Posterior pole color fundus photograph, 848 by 848 pixels, camera: NIDEK AFC-230
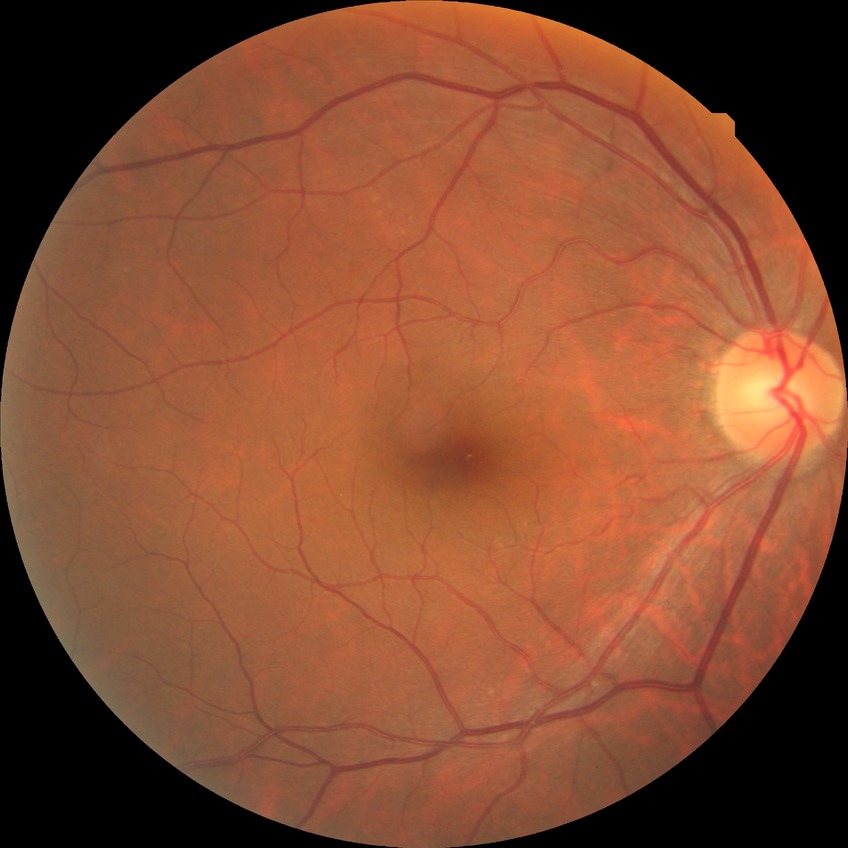
Modified Davis classification is no diabetic retinopathy.